NIDEK AFC-230 fundus camera, modified Davis grading, nonmydriatic, color fundus image — 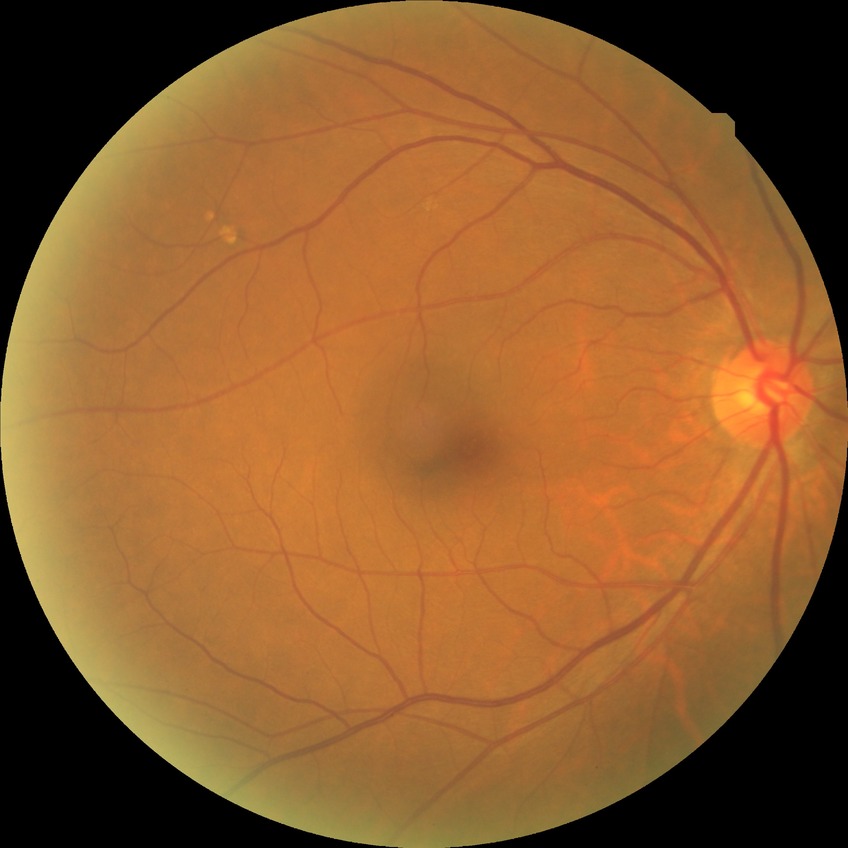
  davis_grade: no diabetic retinopathy